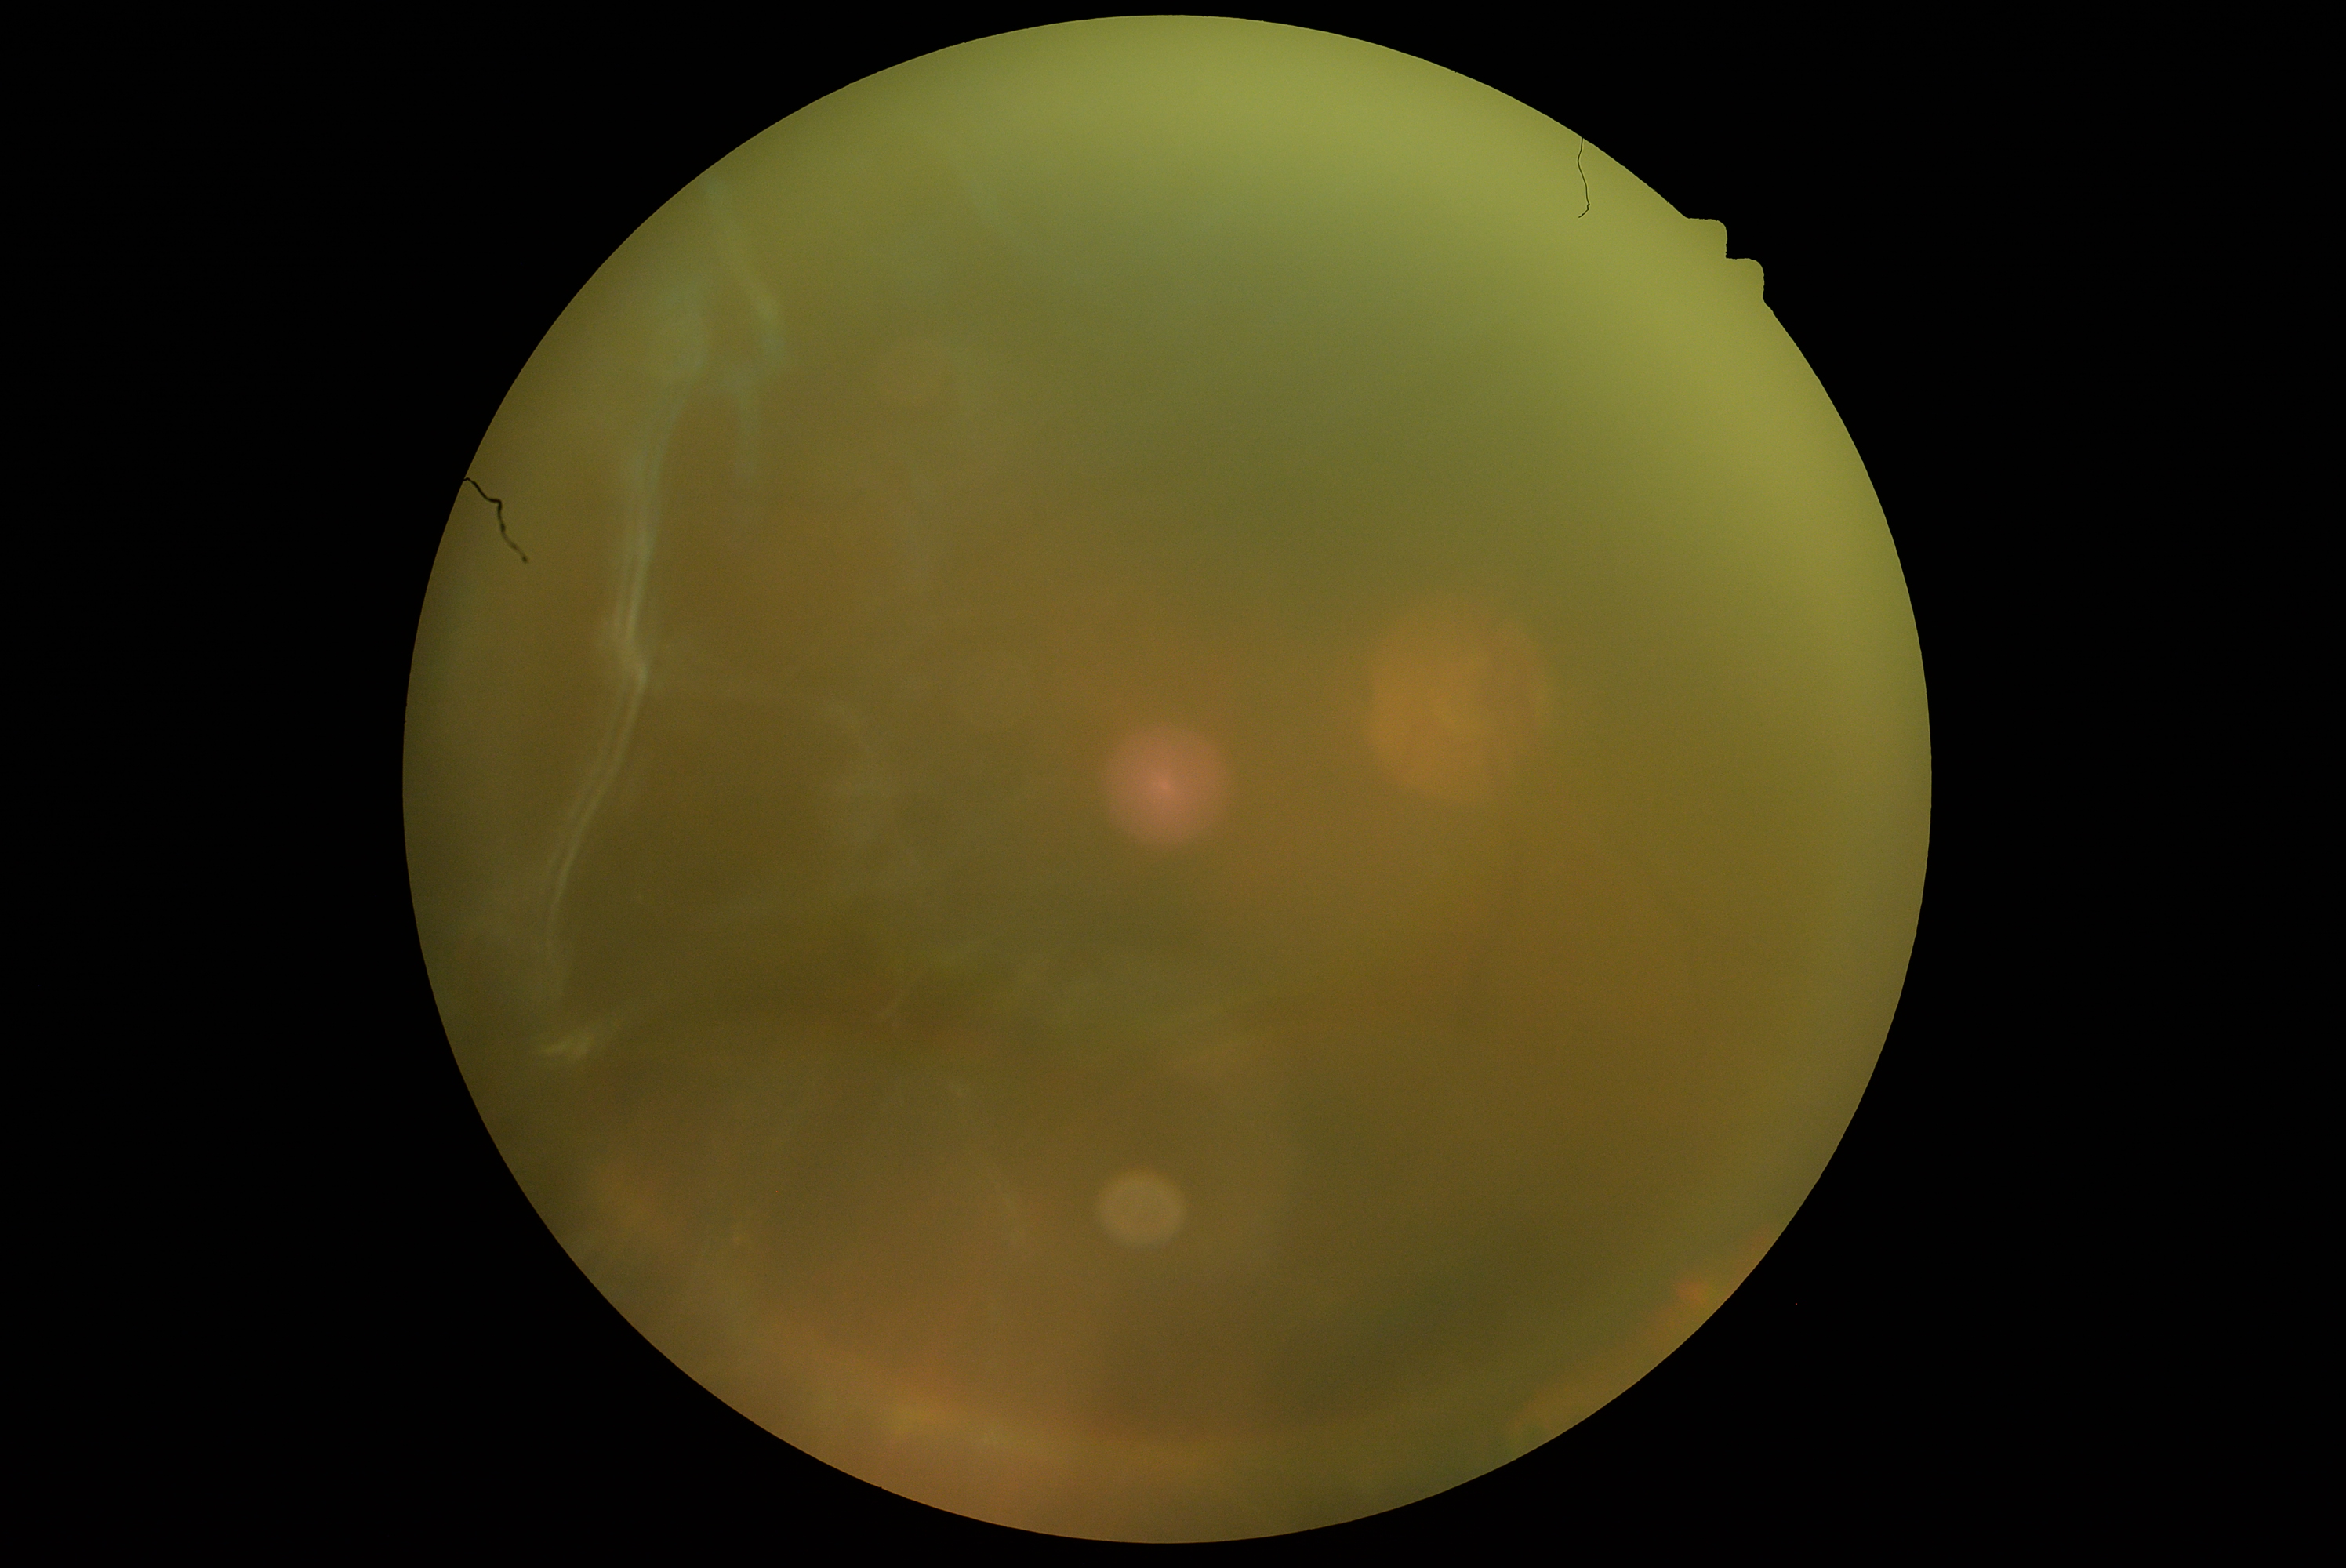 Findings:
- diabetic retinopathy (DR): ungradable due to poor image quality